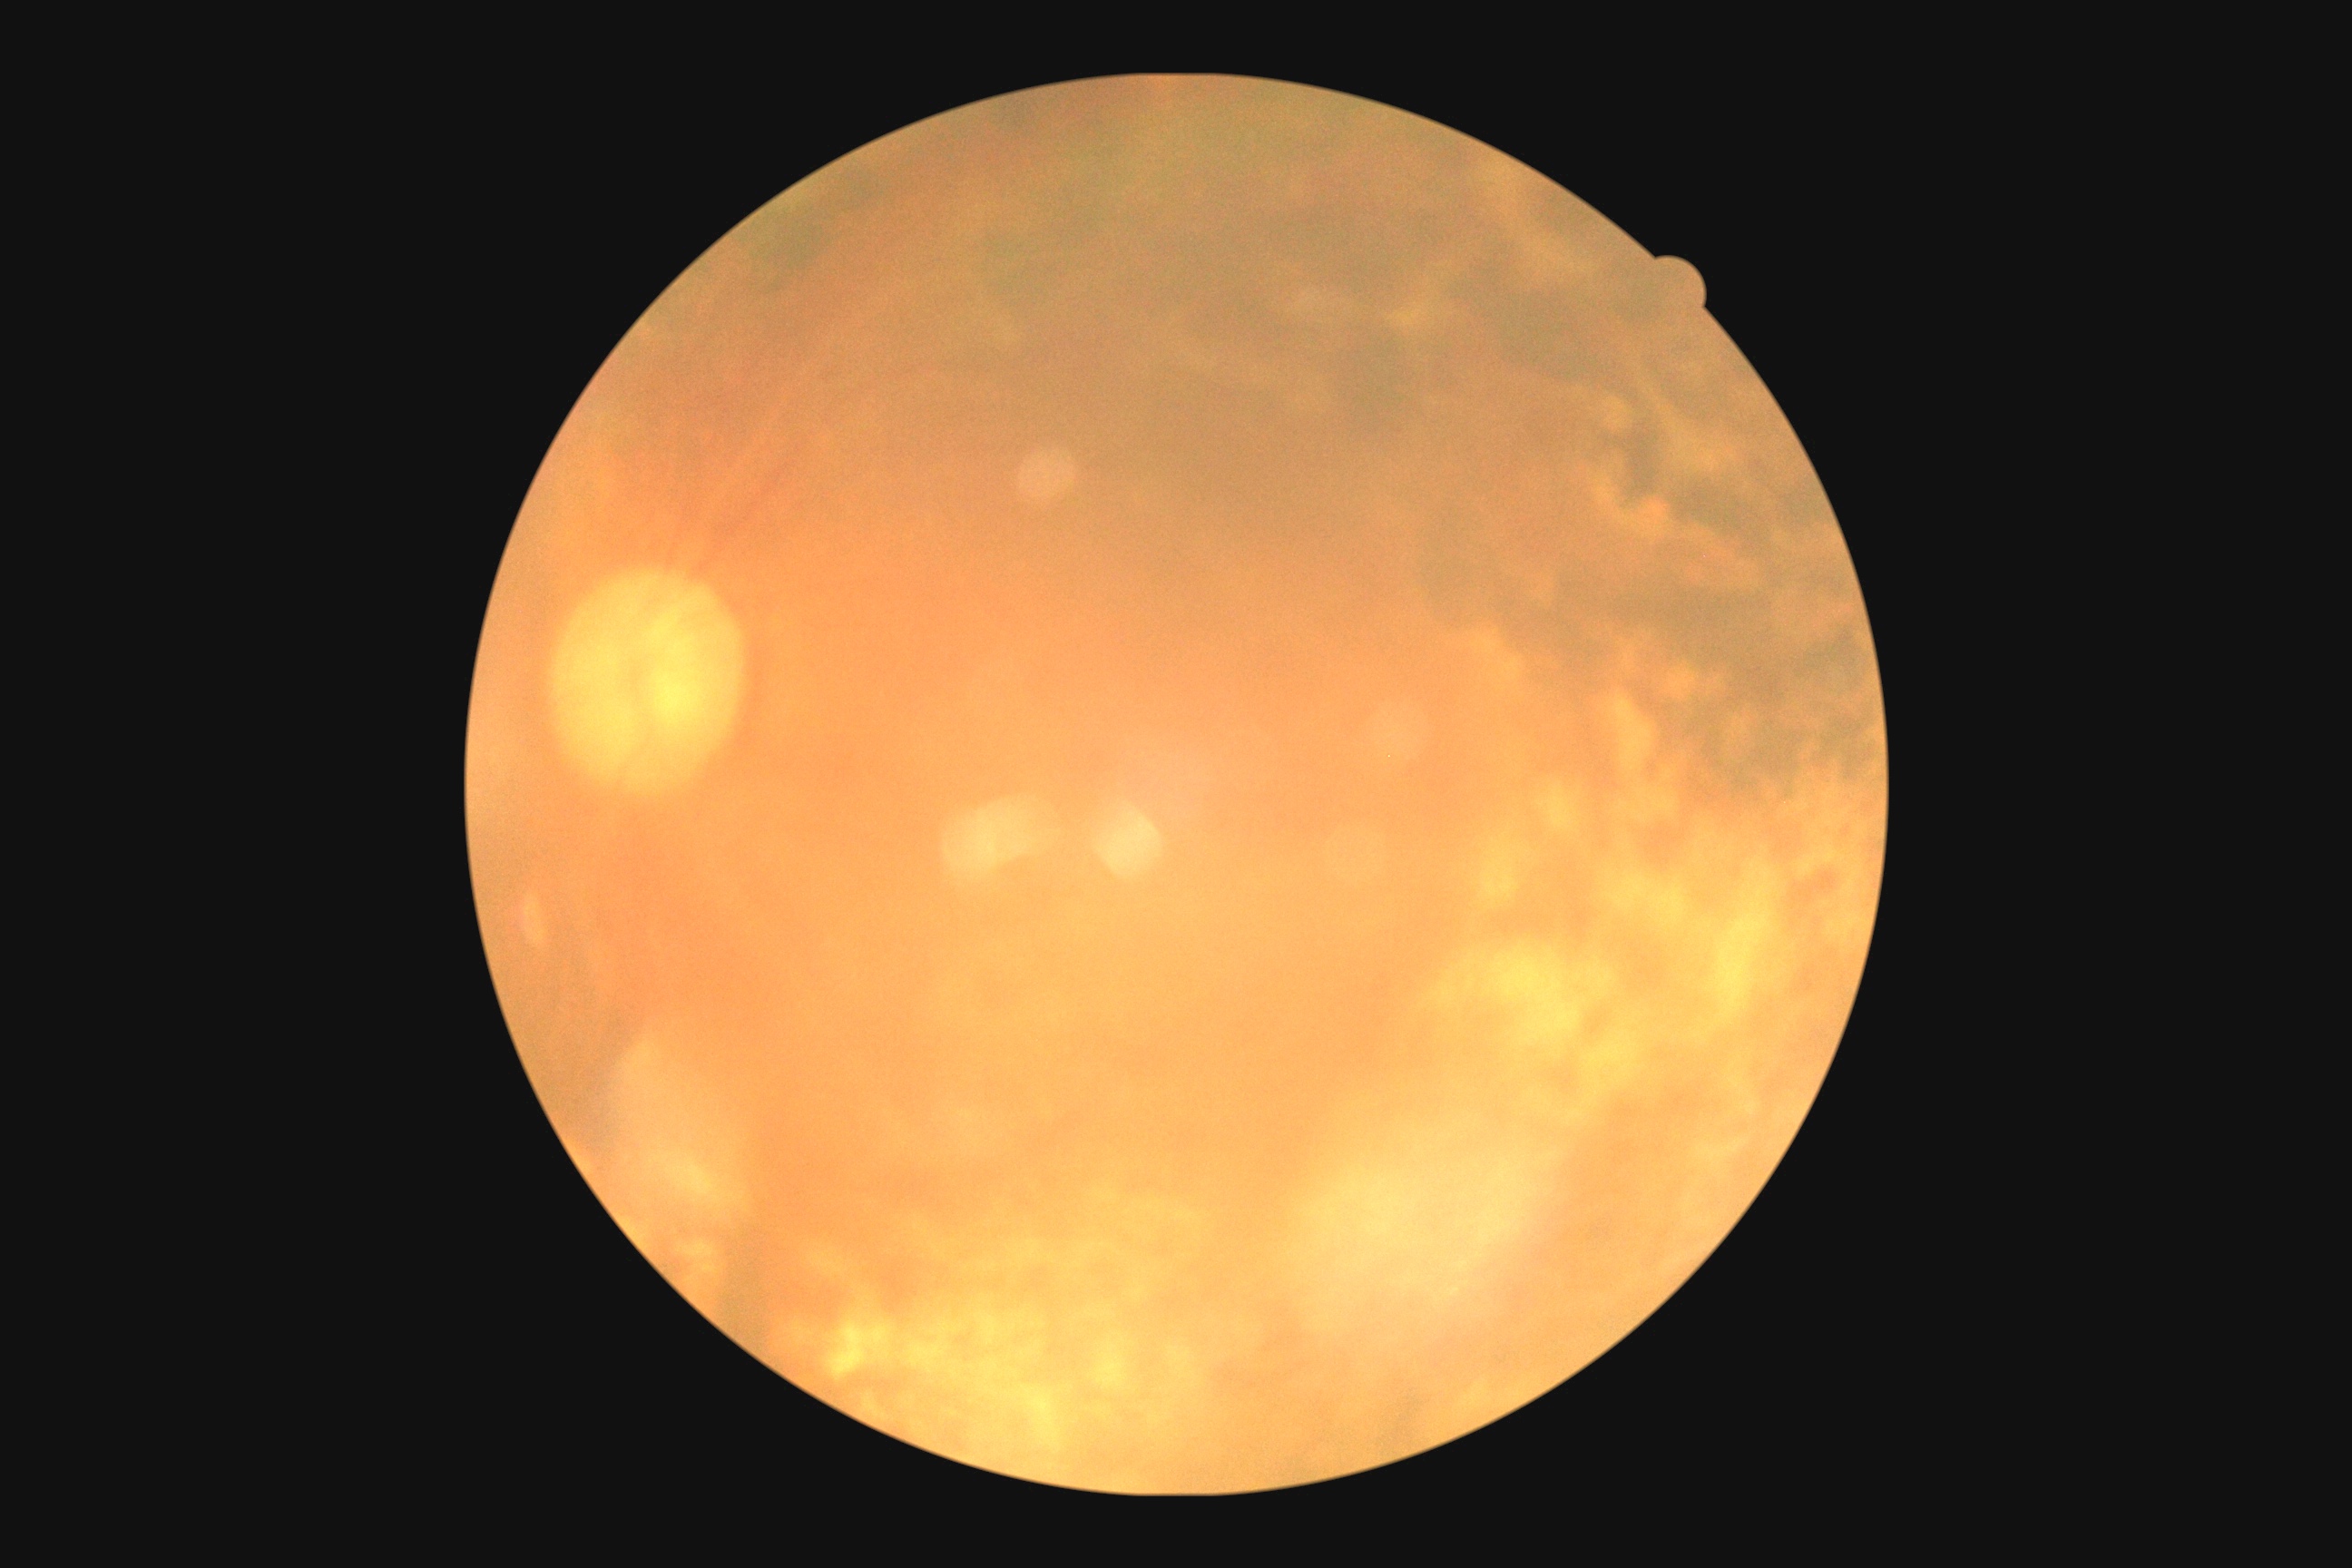

DR grade is ungradable.